Image size 640x480. Acquired on the Clarity RetCam 3. Wide-field fundus photograph of an infant
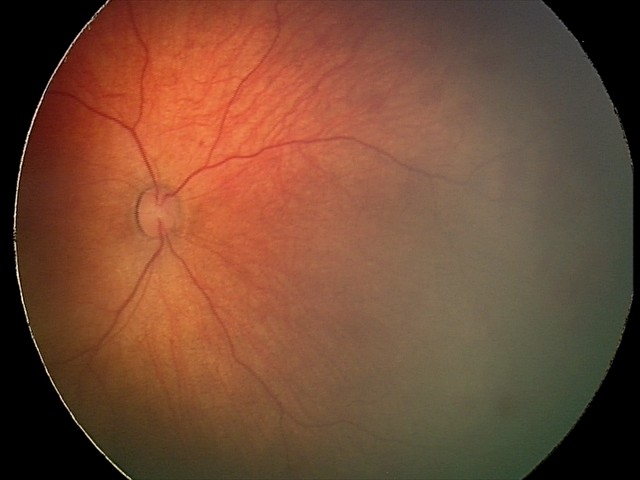

Screening series with retinal hemorrhages.